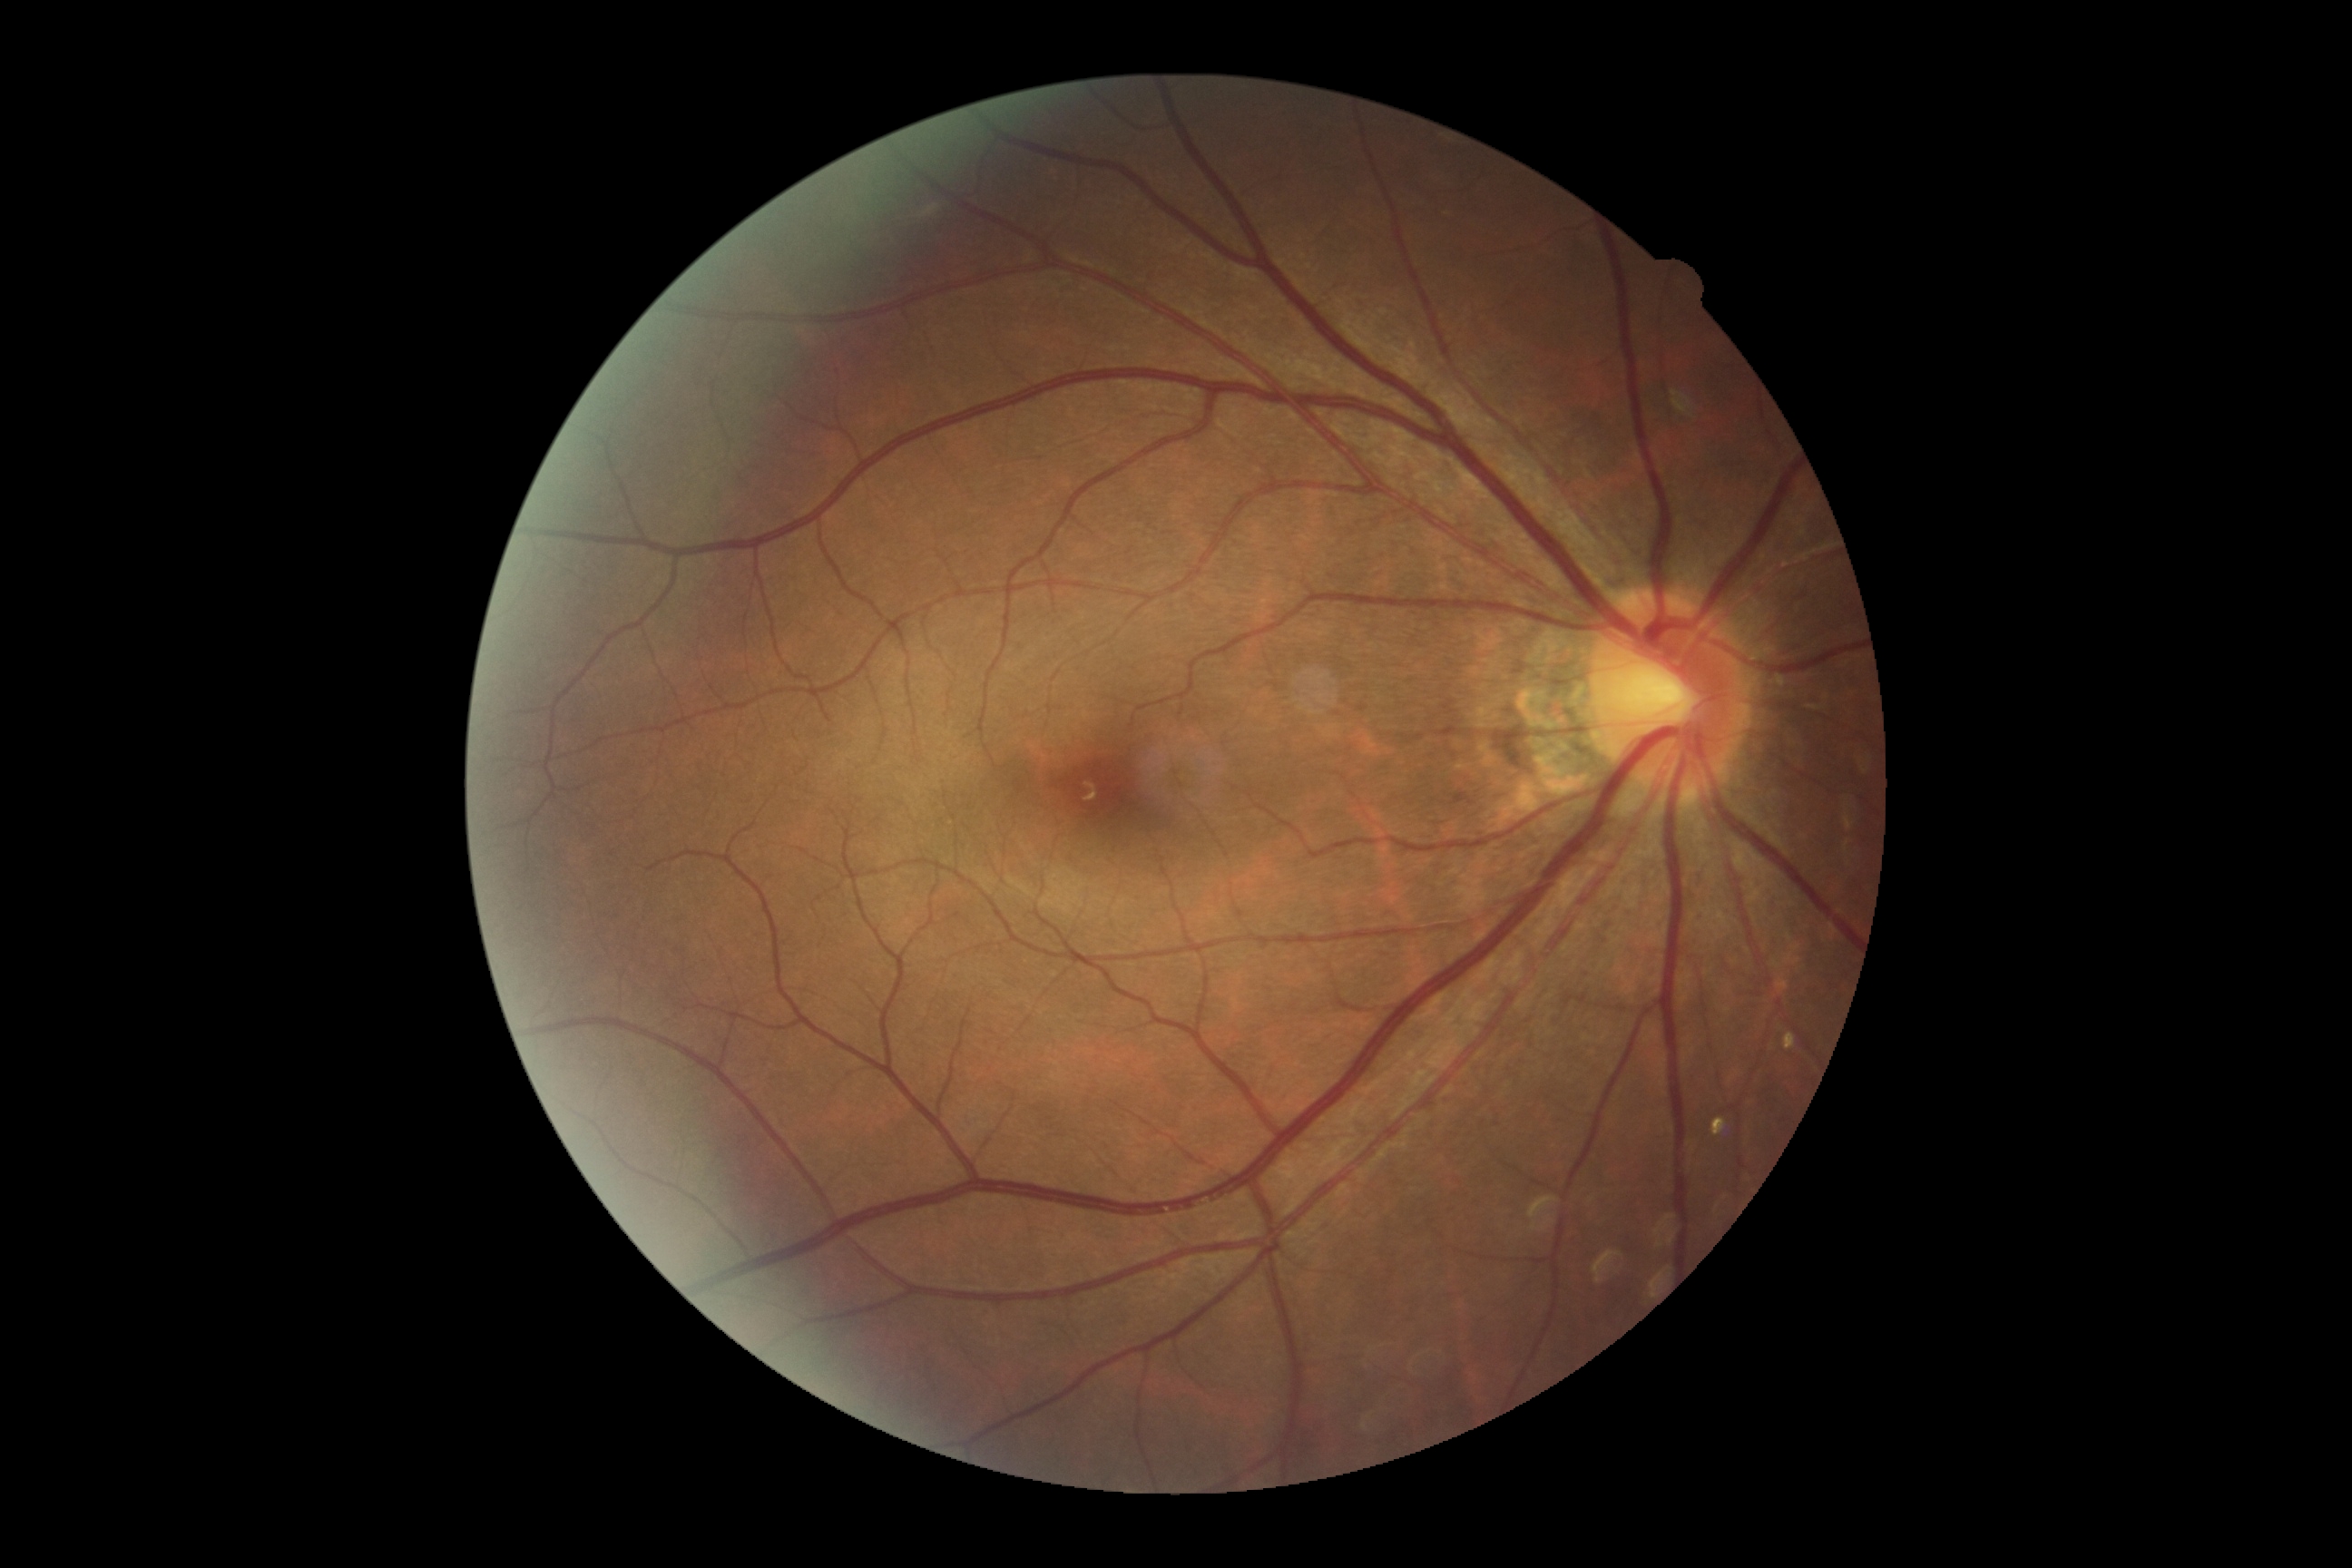

DR stage: grade 0.